Phoenix ICON, 100° FOV · 1240x1240px · pediatric retinal photograph (wide-field) — 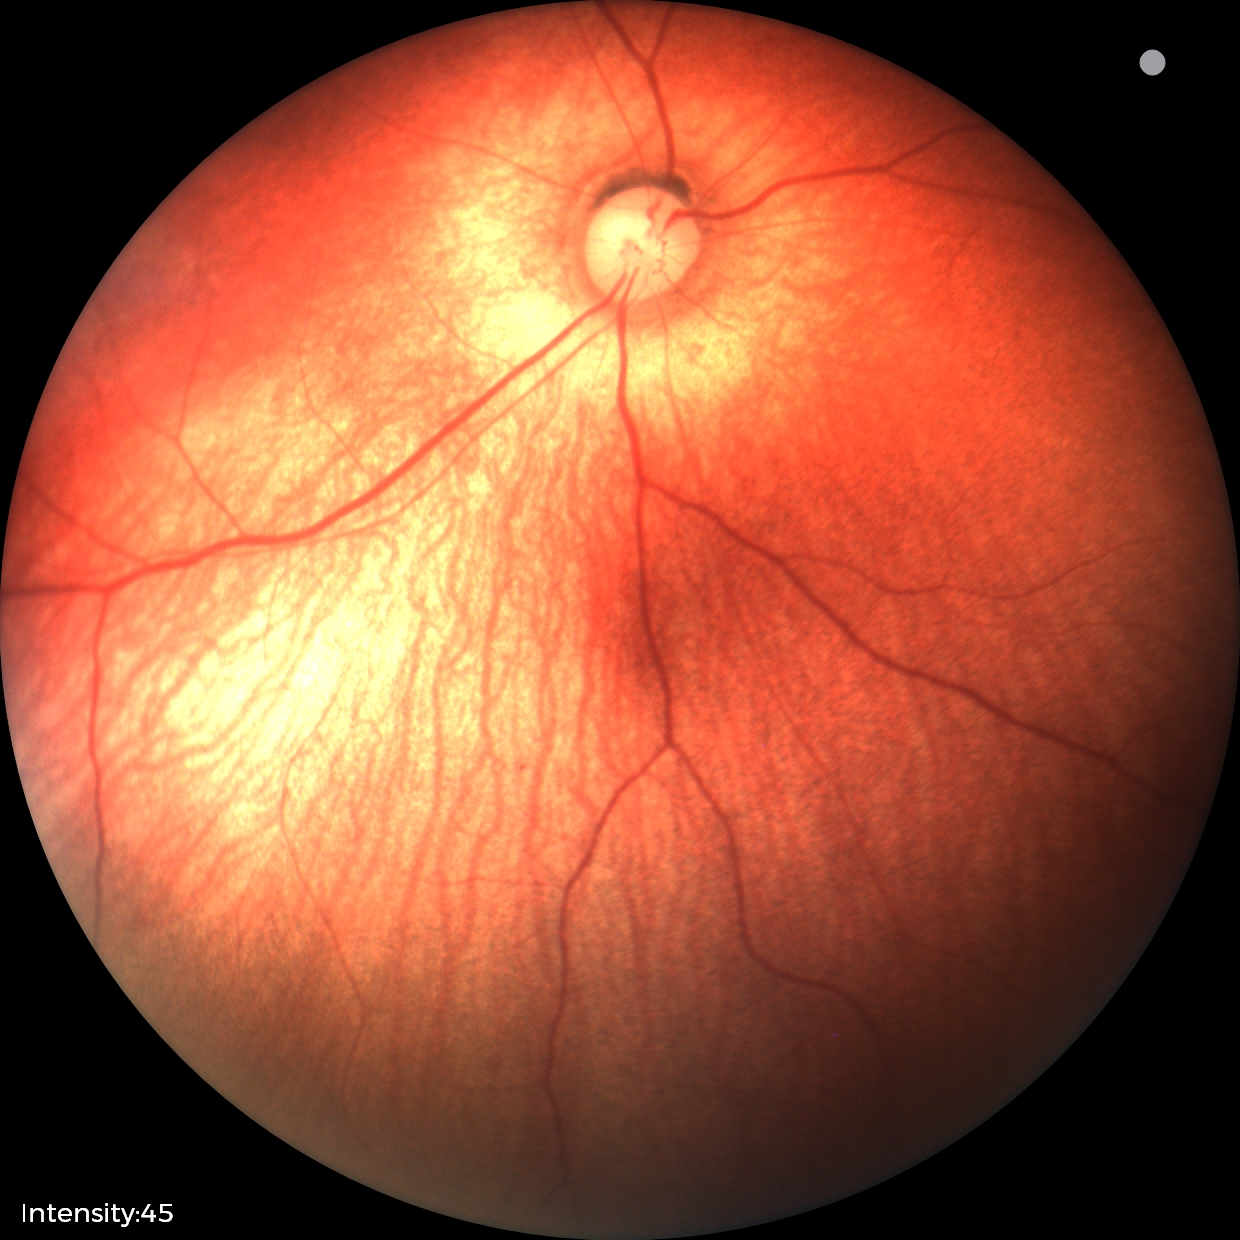

Screening: normal fundus examination.